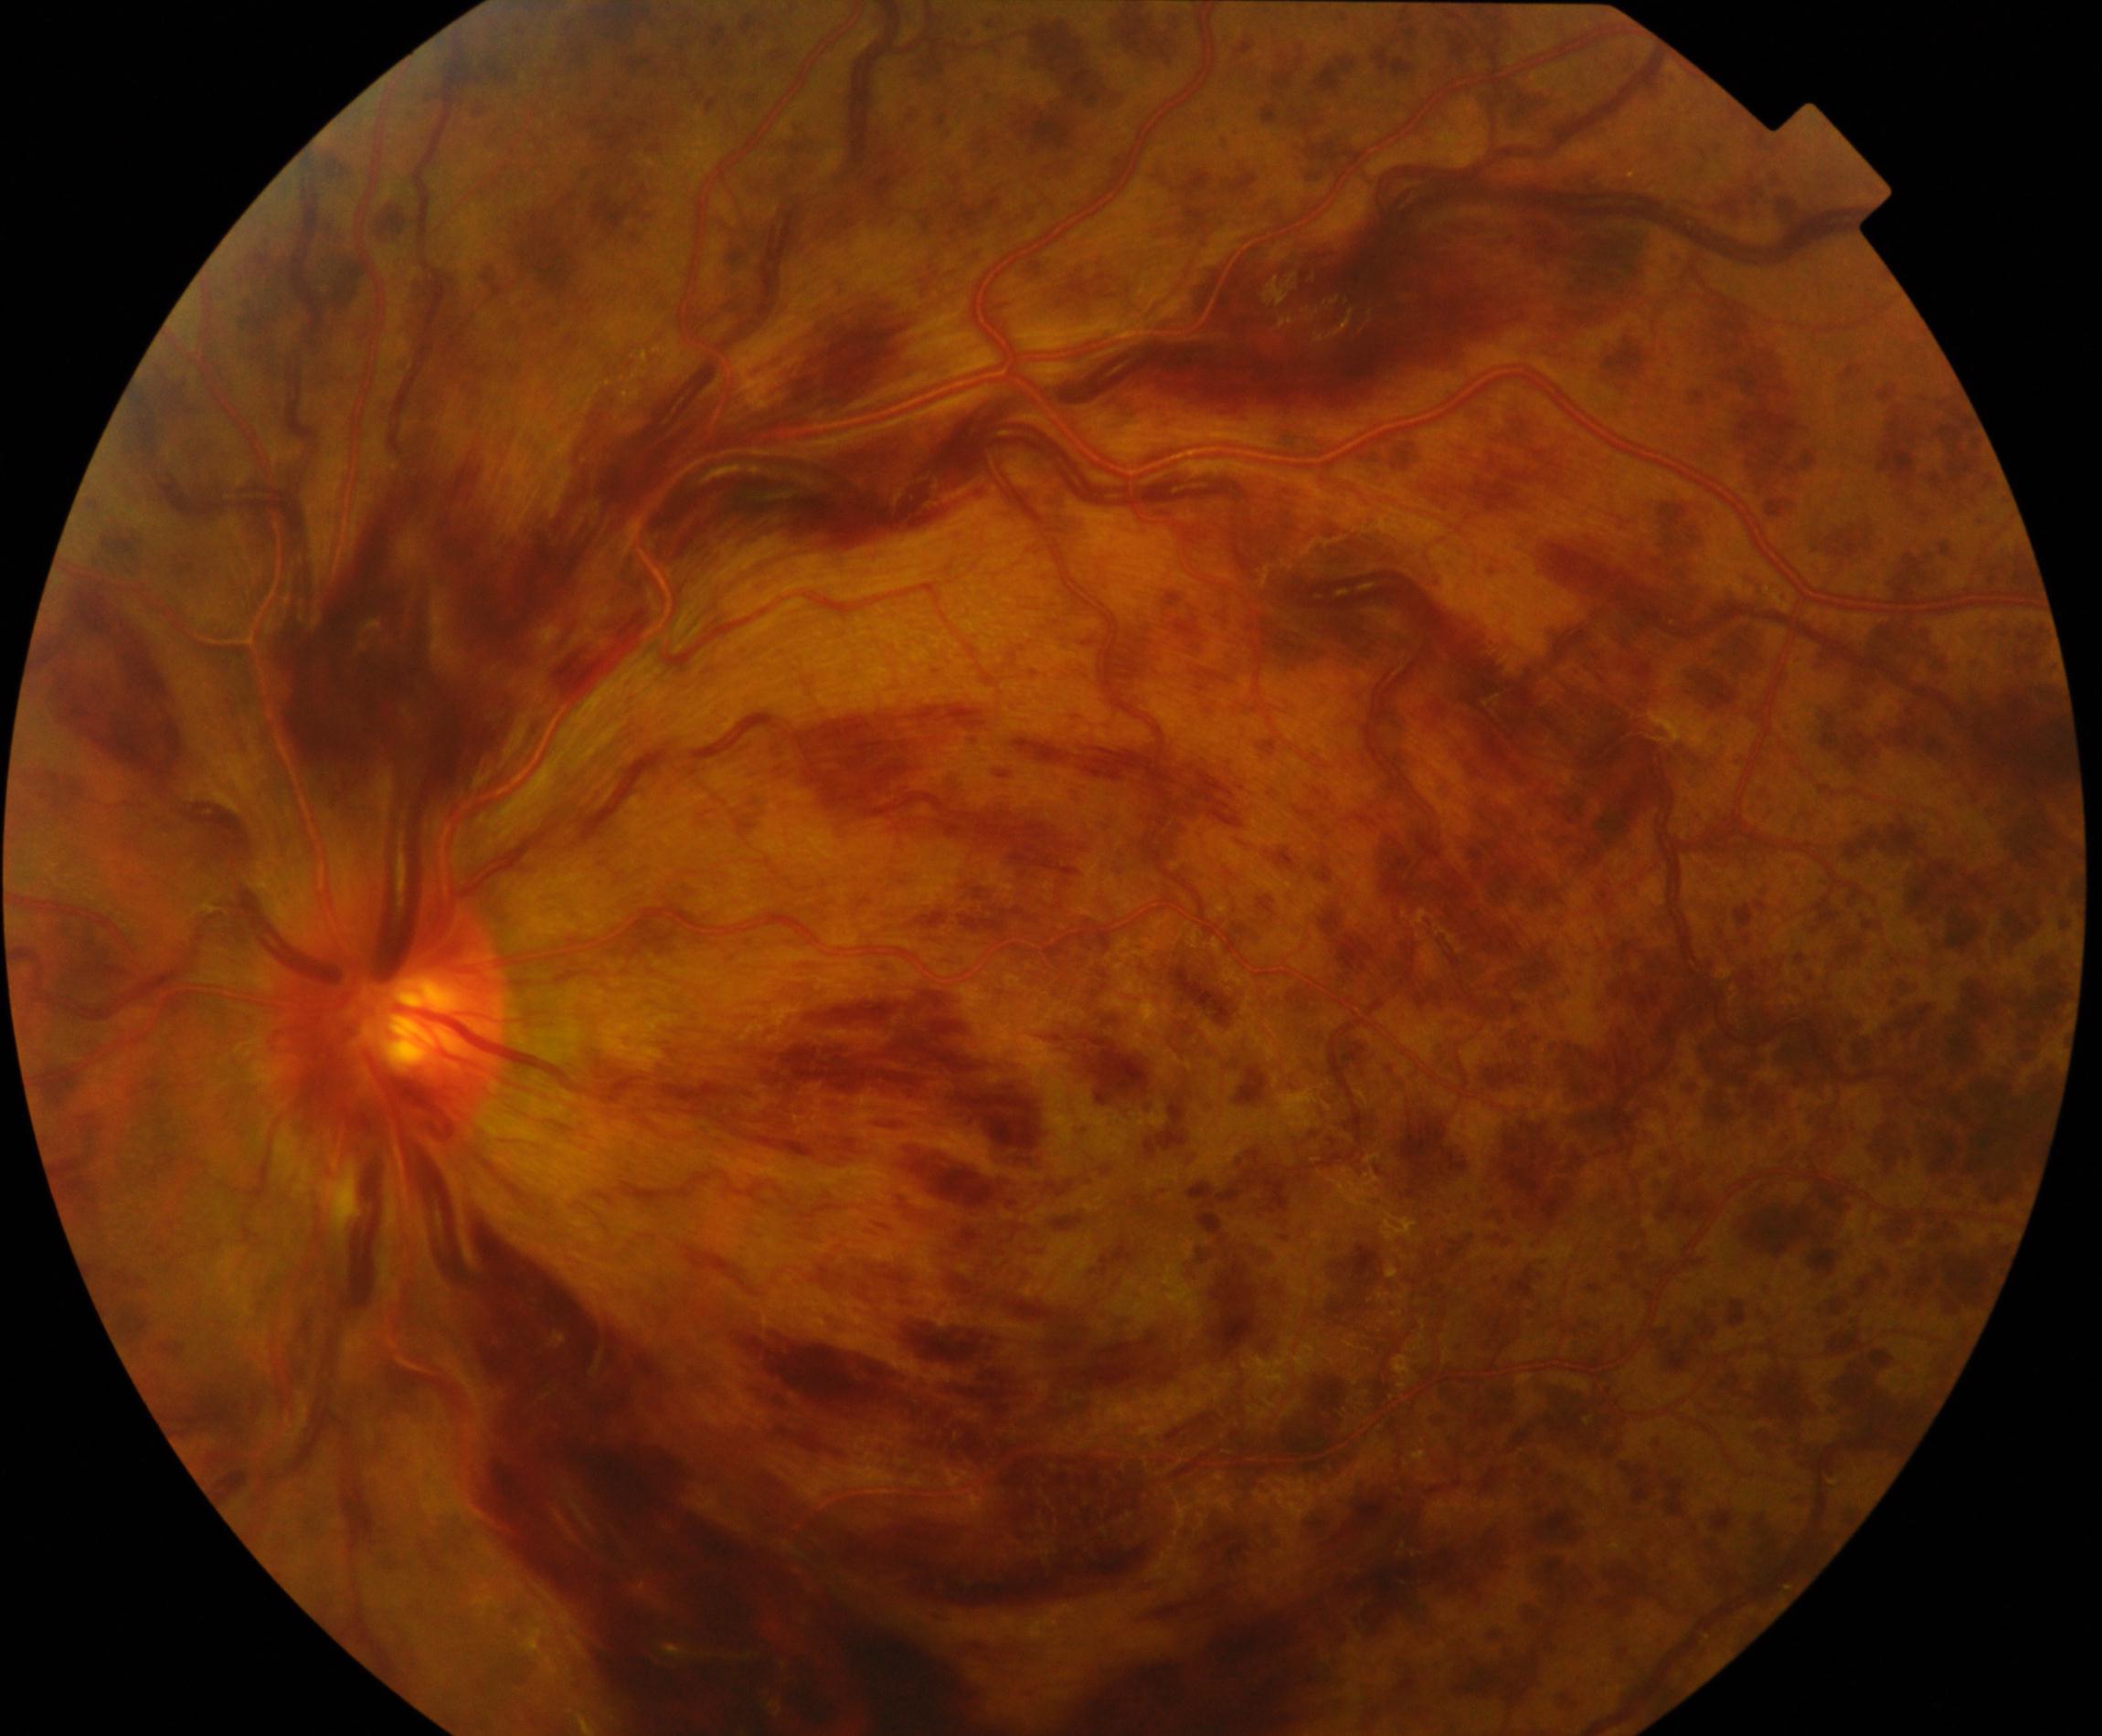
Diagnosis: central retinal vein occlusion. Features include tortuosity and dilatation of all branches of veins, with dot, blot, and flame hemorrhages, sometimes with cotton-wool spots or hard exudates.